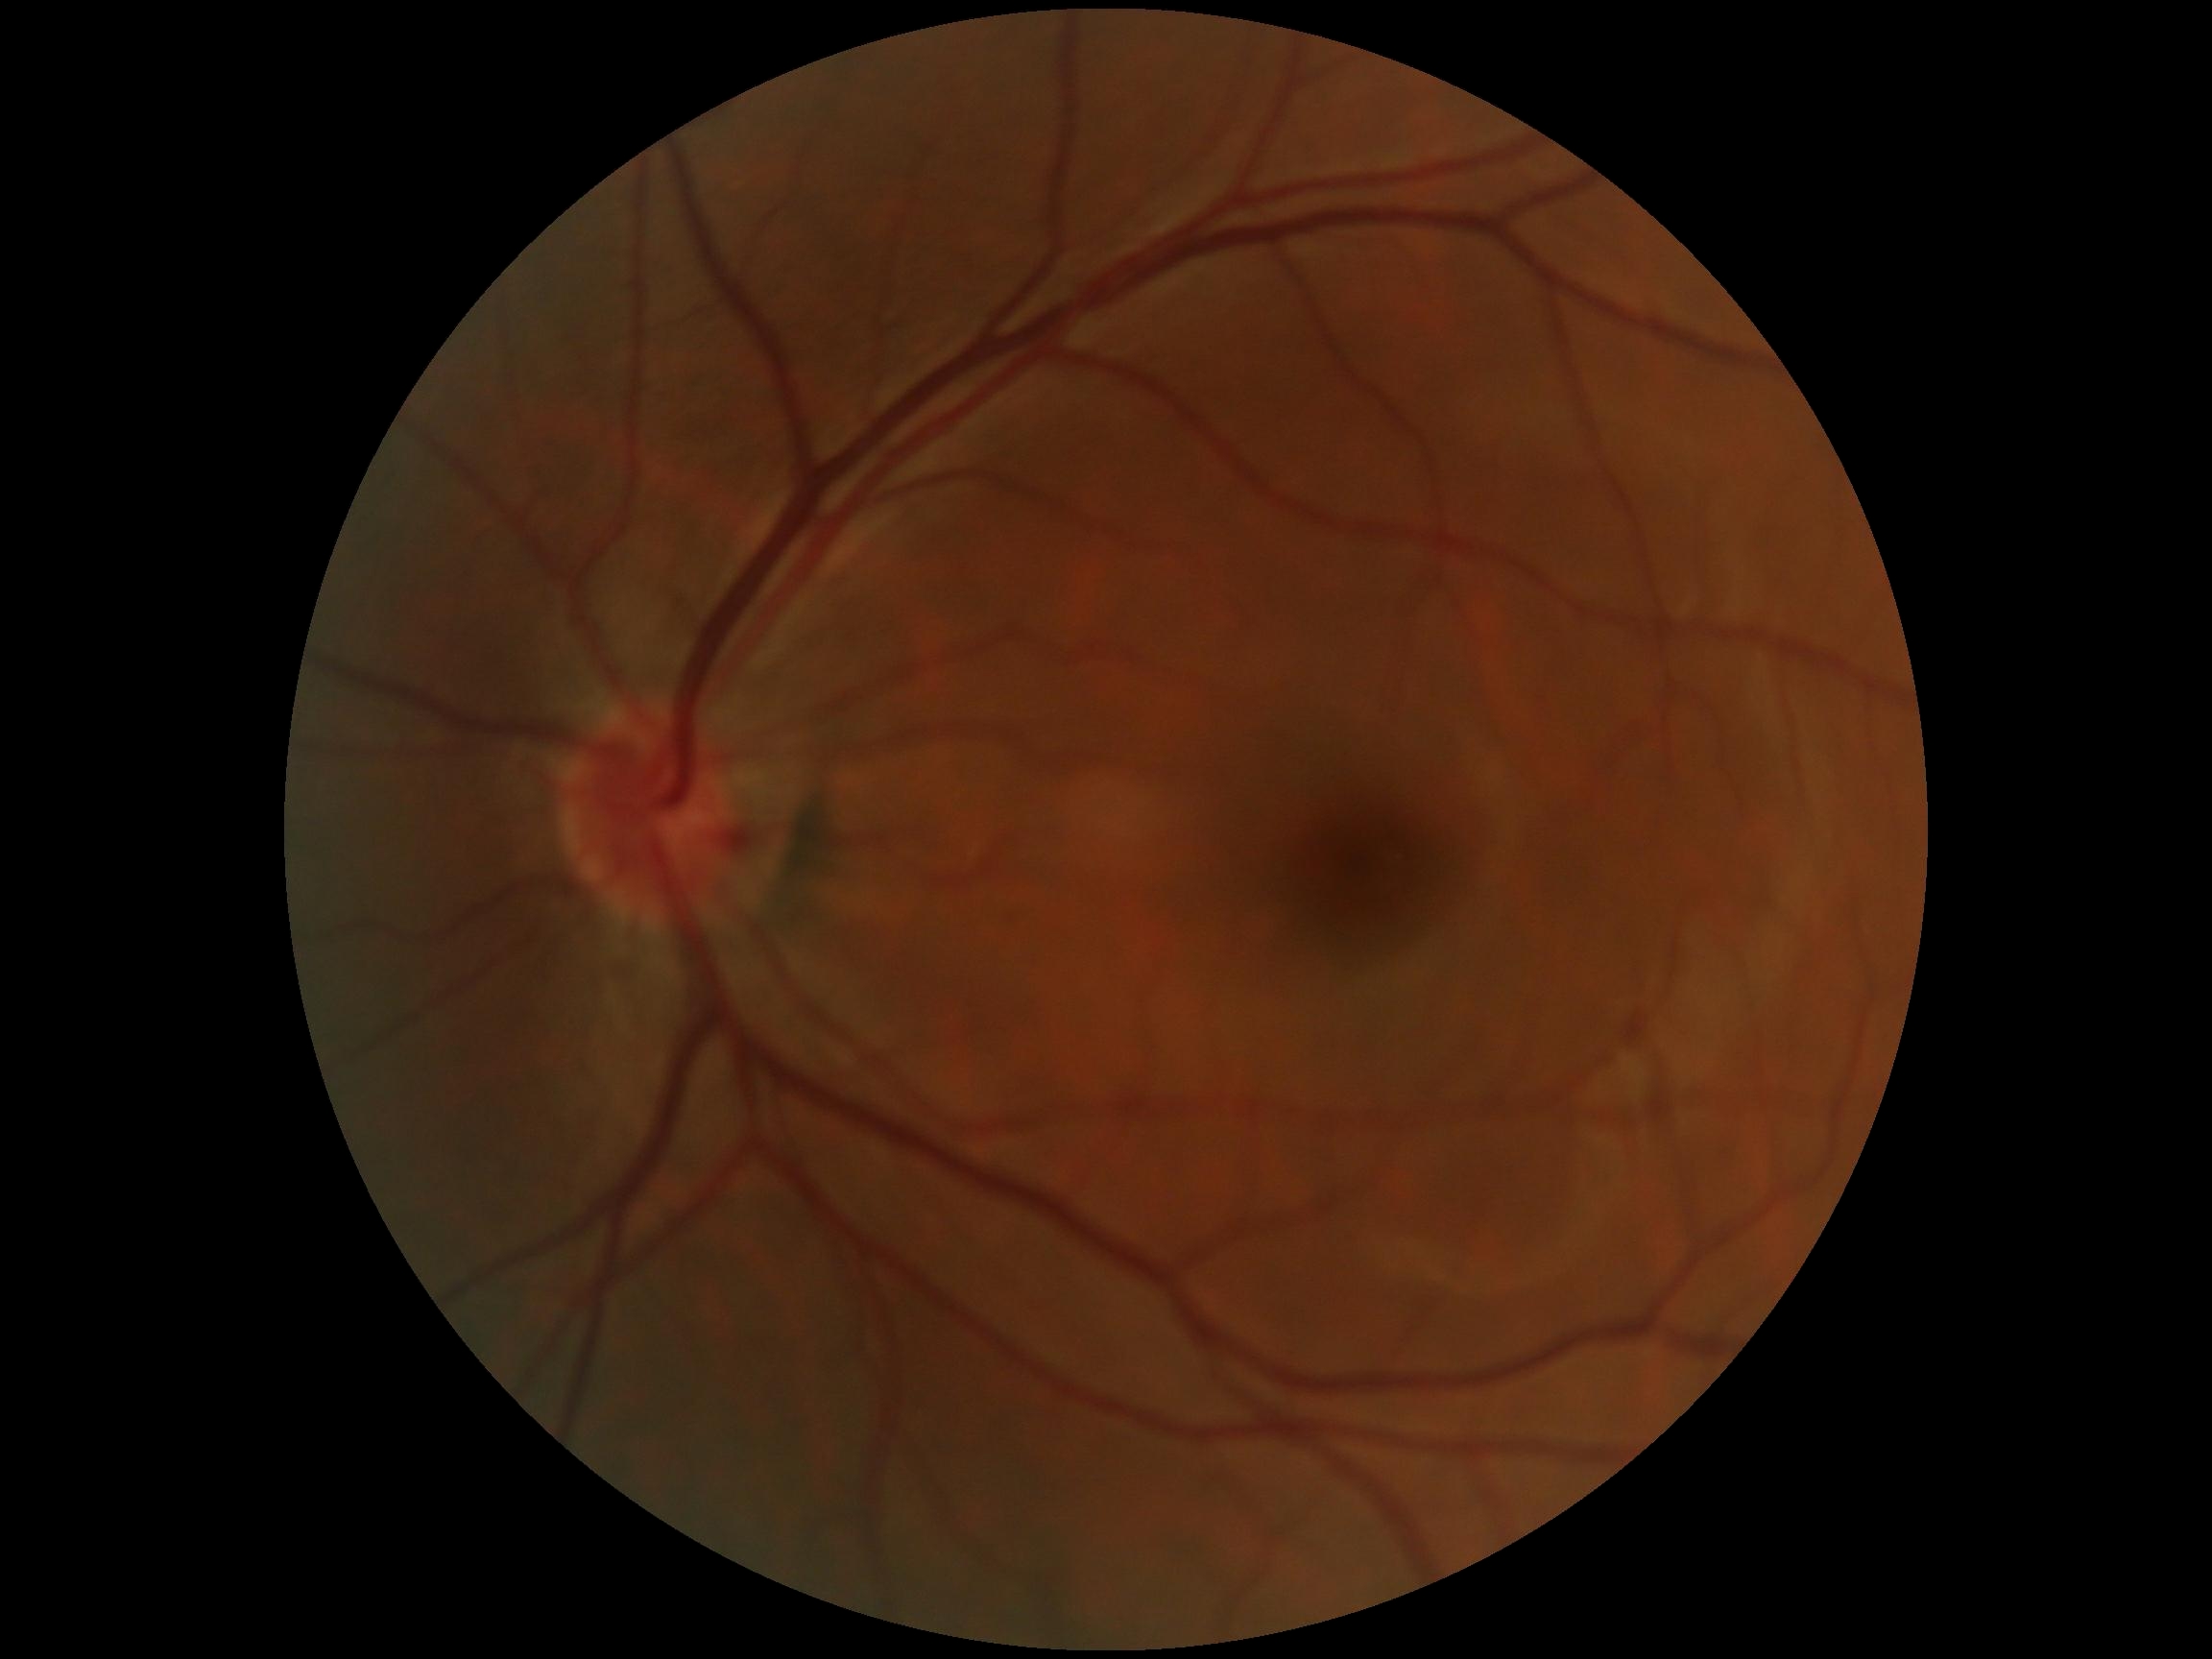
No DR findings. Diabetic retinopathy (DR) is grade 0 (no apparent retinopathy).